Pediatric wide-field fundus photograph. Acquired on the Phoenix ICON.
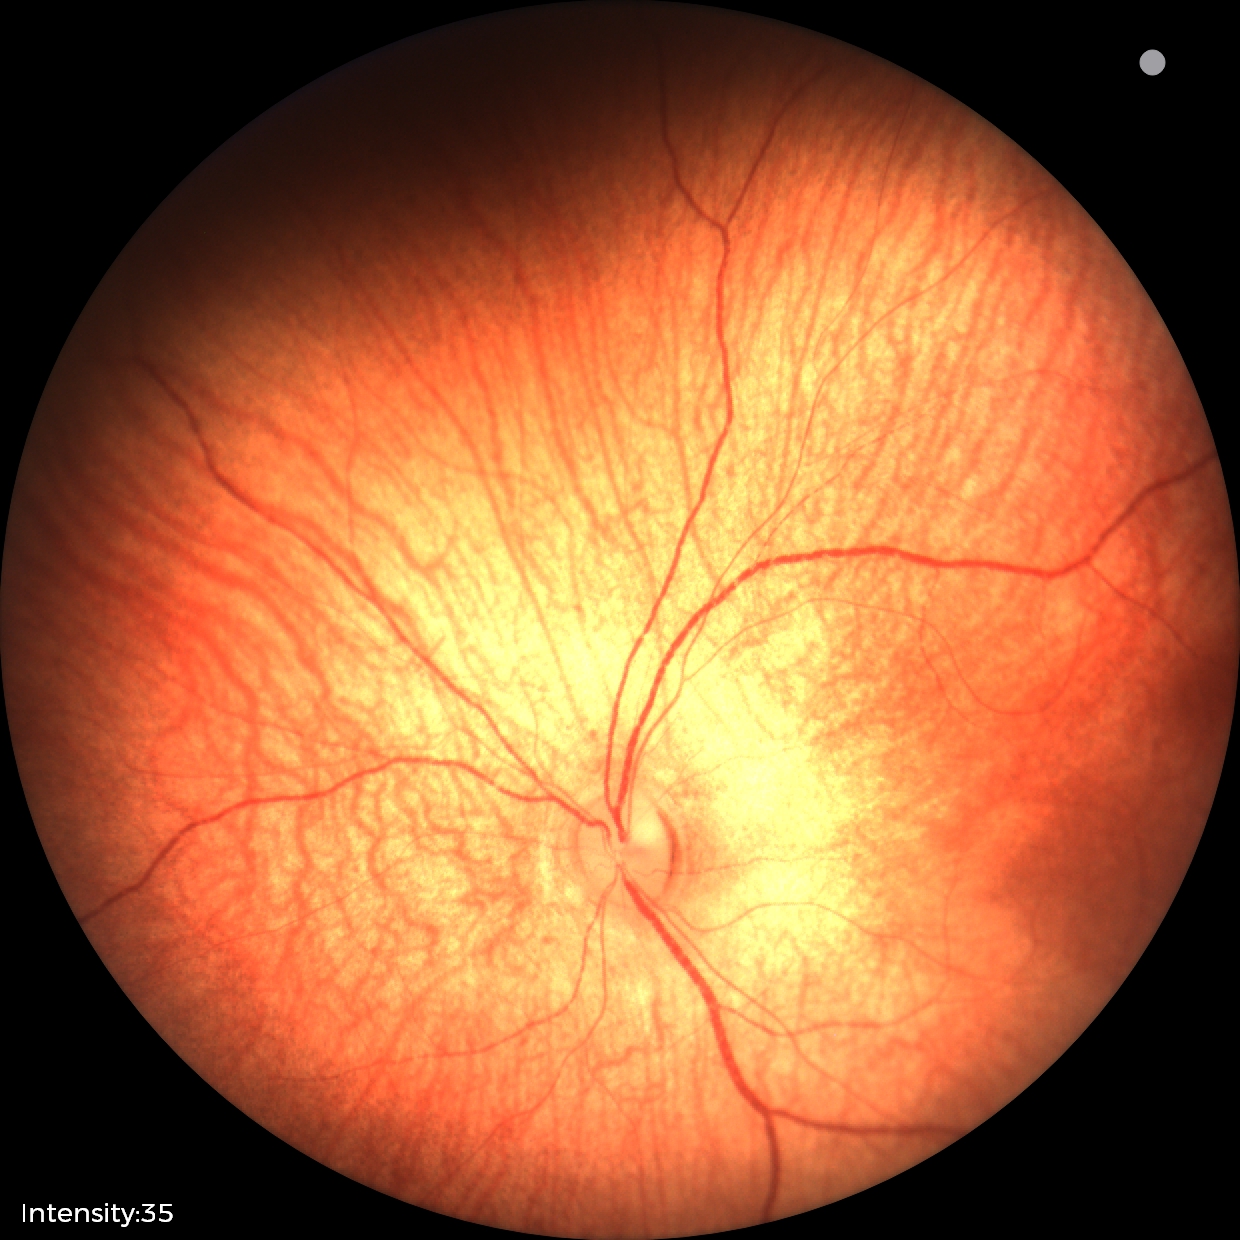 Physiological retinal appearance for postconceptual age.